Woman · optic disc at the center of the field · axial length (AL): 23.79 mm · 30° field of view · age 72 · intraocular pressure 14 mmHg · Topcon TRC-NW400 · undilated pupil · 2212 x 1661 pixels
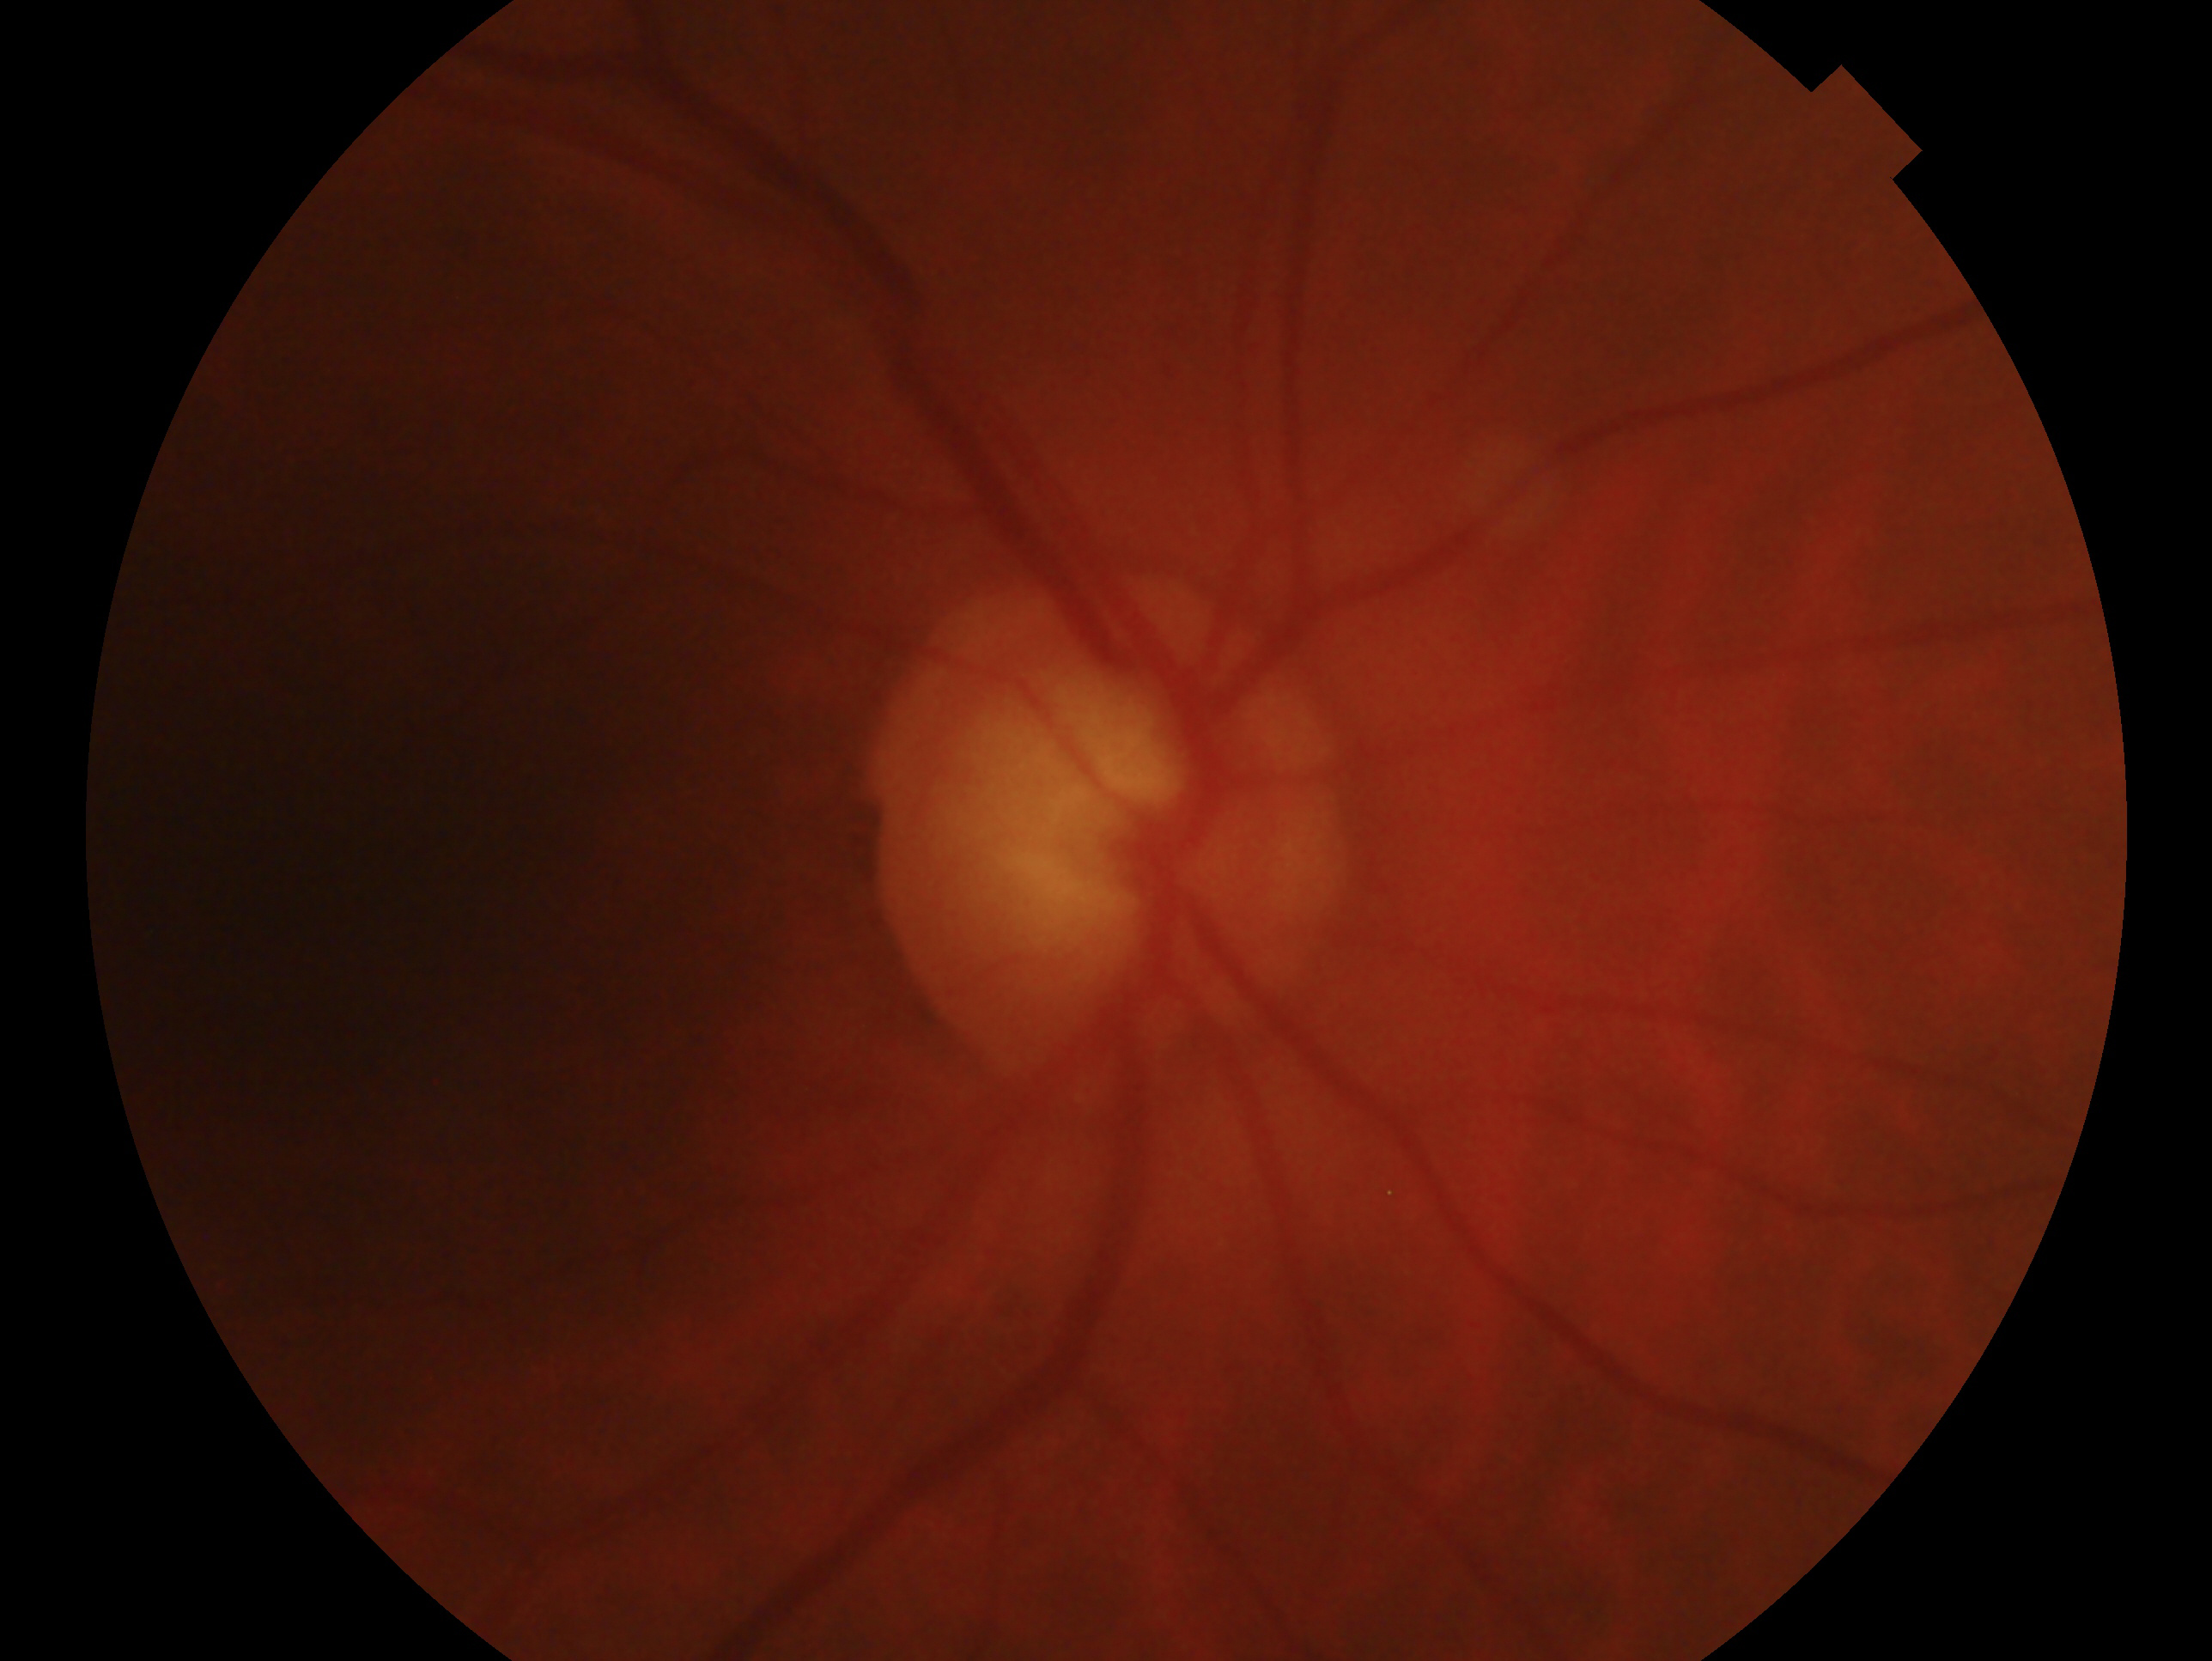 Annotations:
- assessment — glaucoma
- laterality — oculus dexter